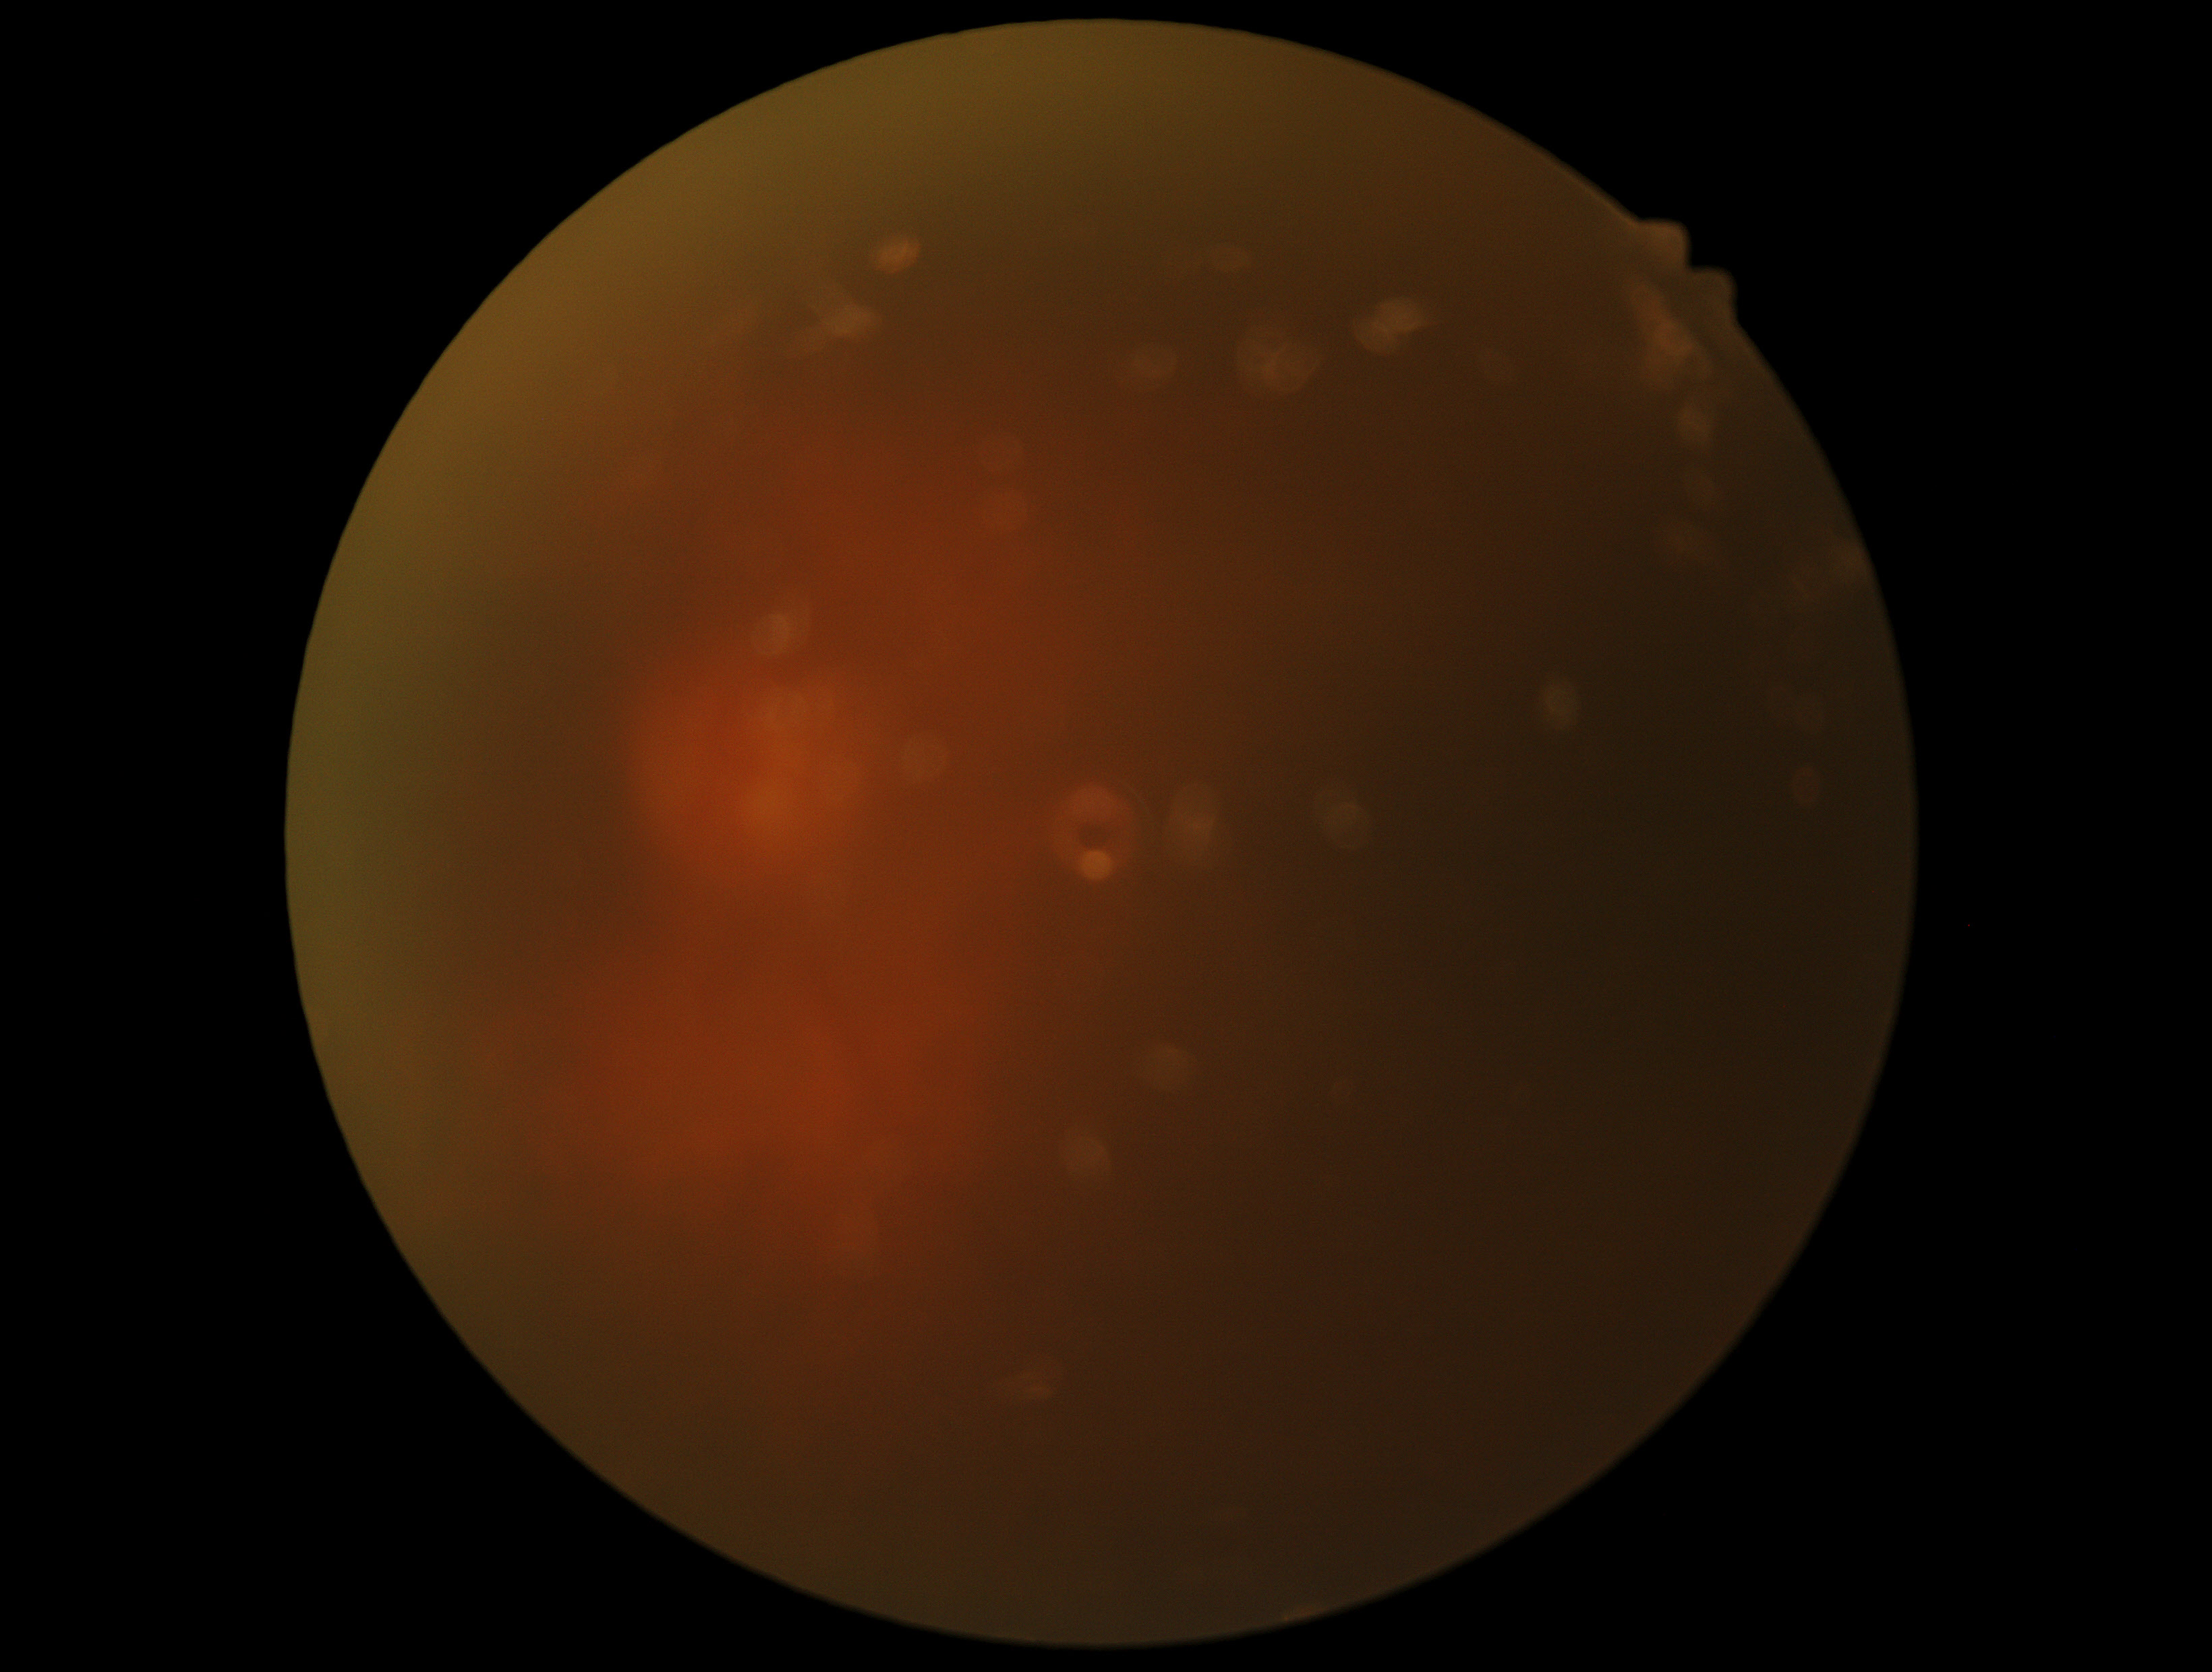

dr_grade: ungradable due to poor image quality
quality: too poor for DR grading